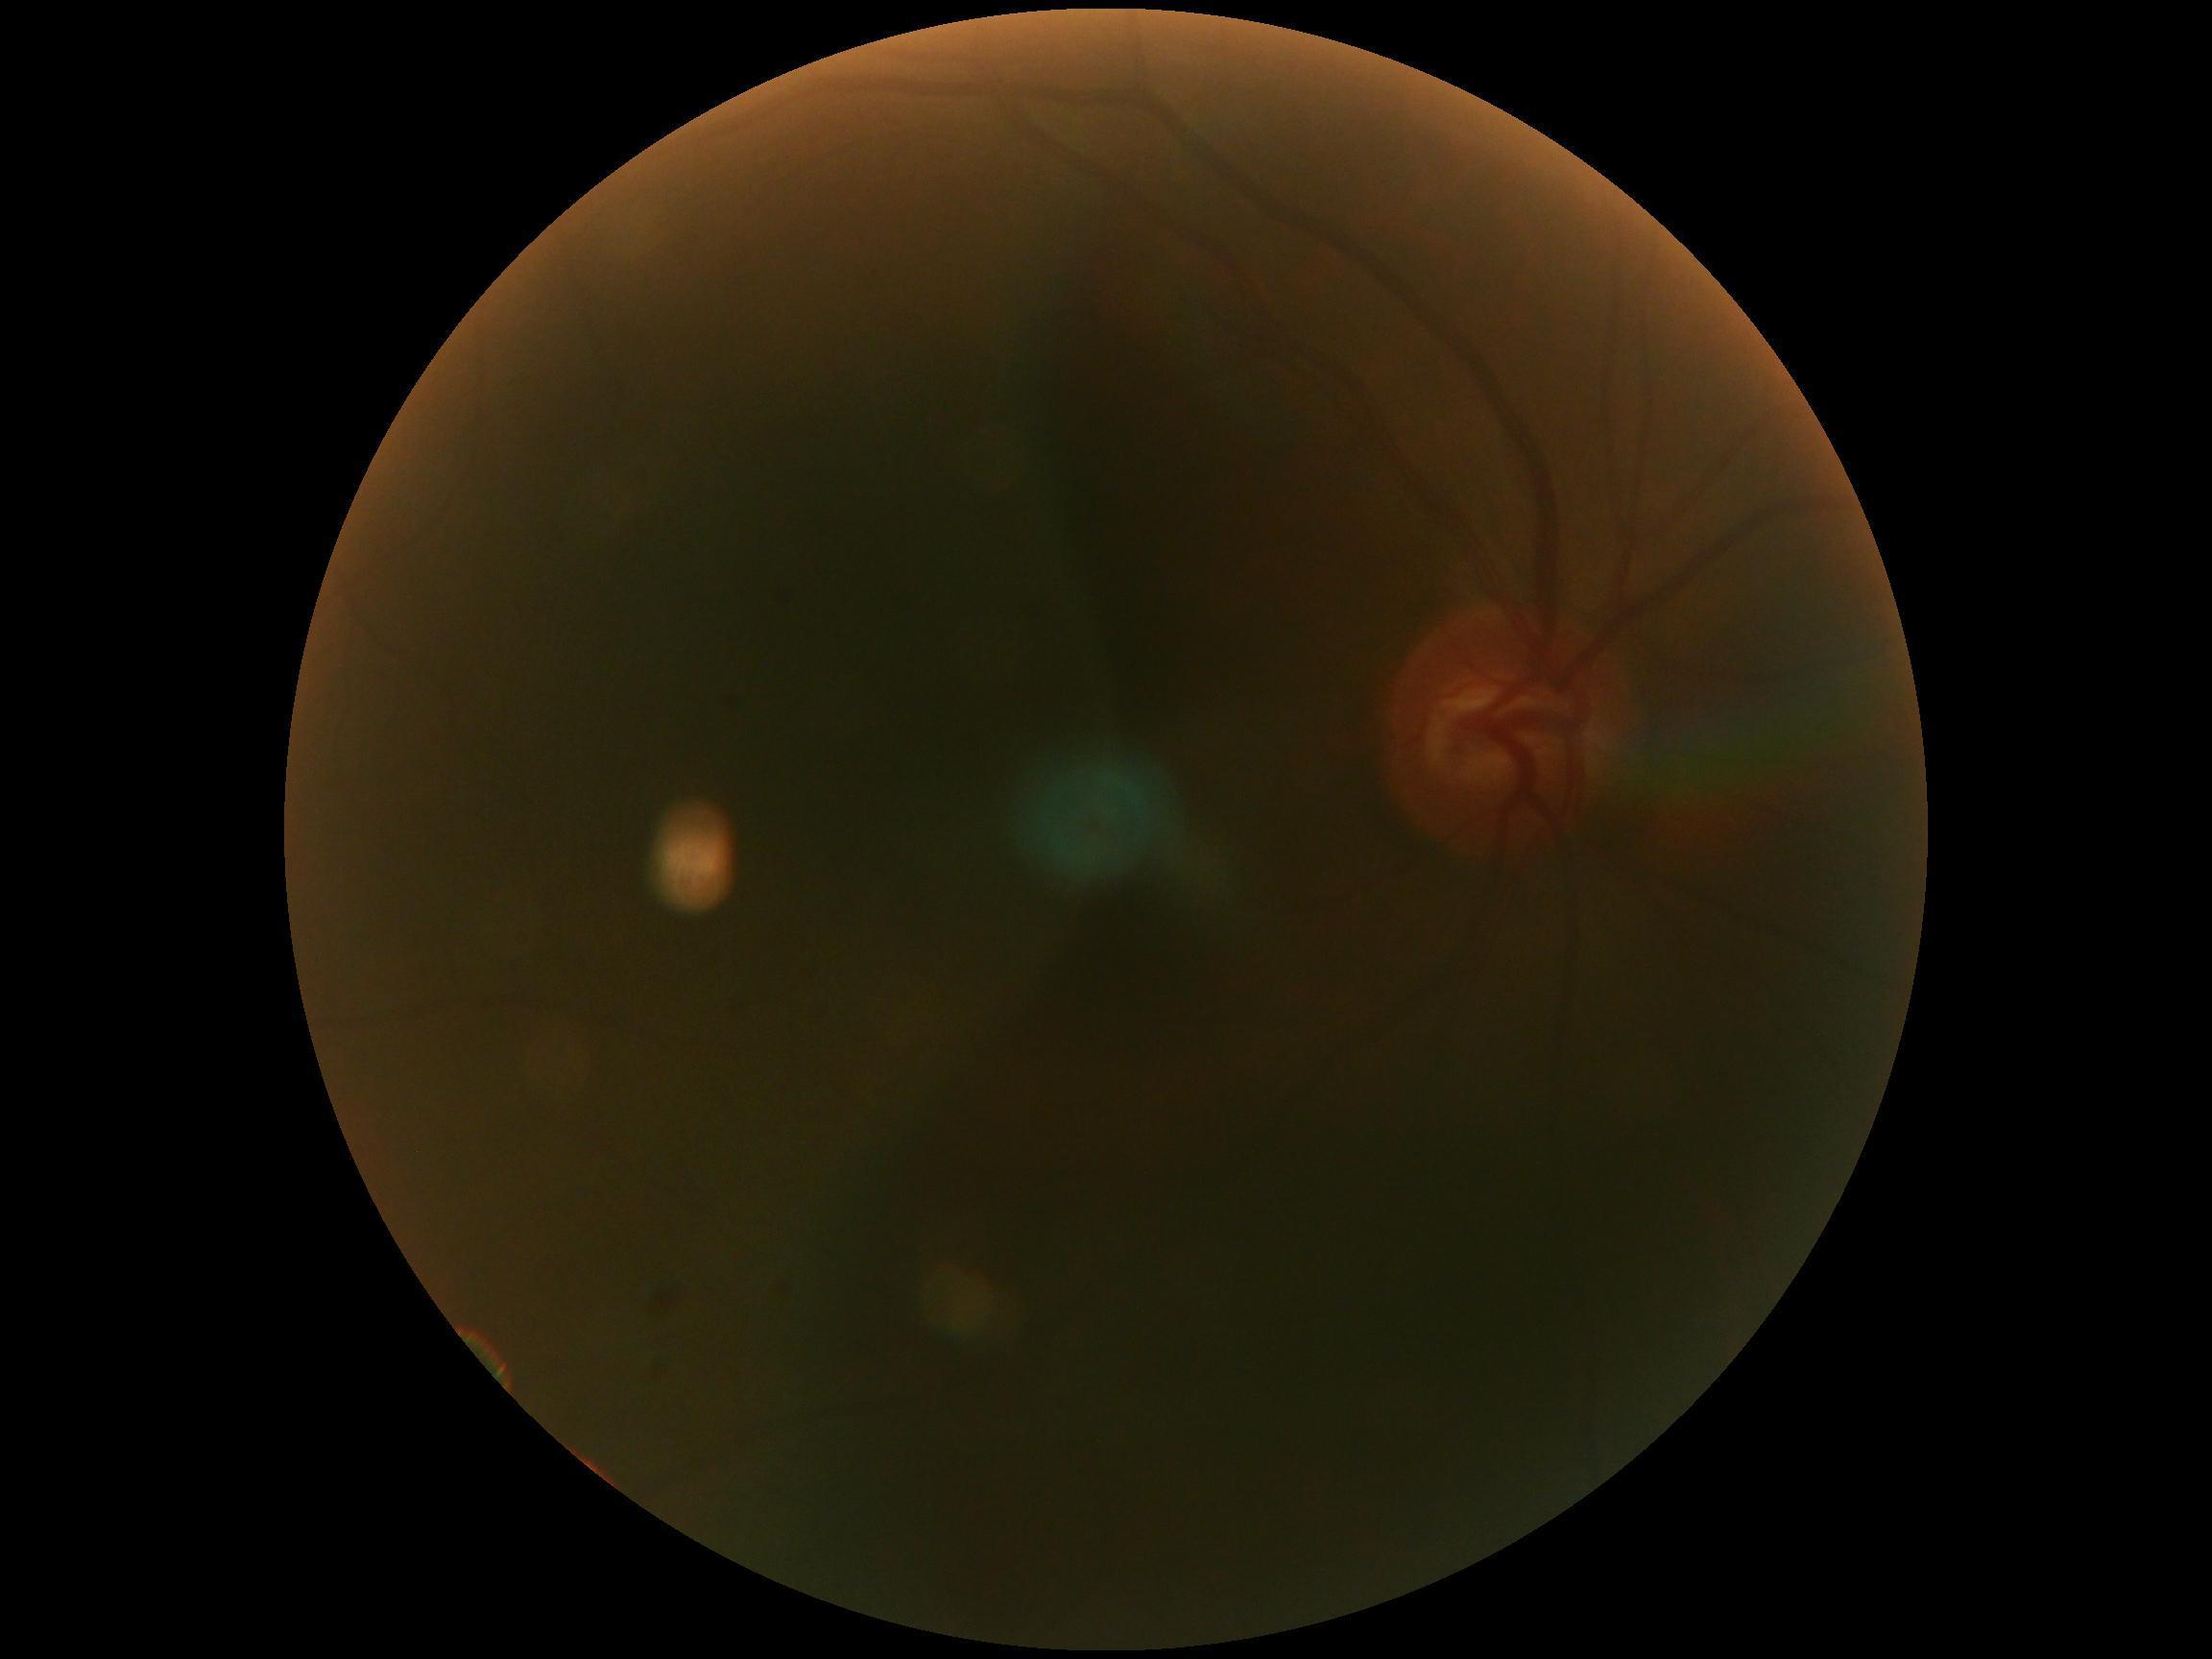

{
  "dr_grade": "ungradable due to poor image quality",
  "quality": "insufficient for DR assessment"
}